Captured without pupil dilation — 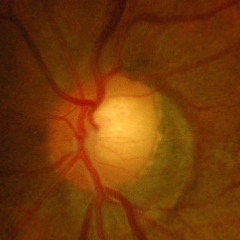 Glaucoma assessment: advanced glaucomatous optic neuropathy.